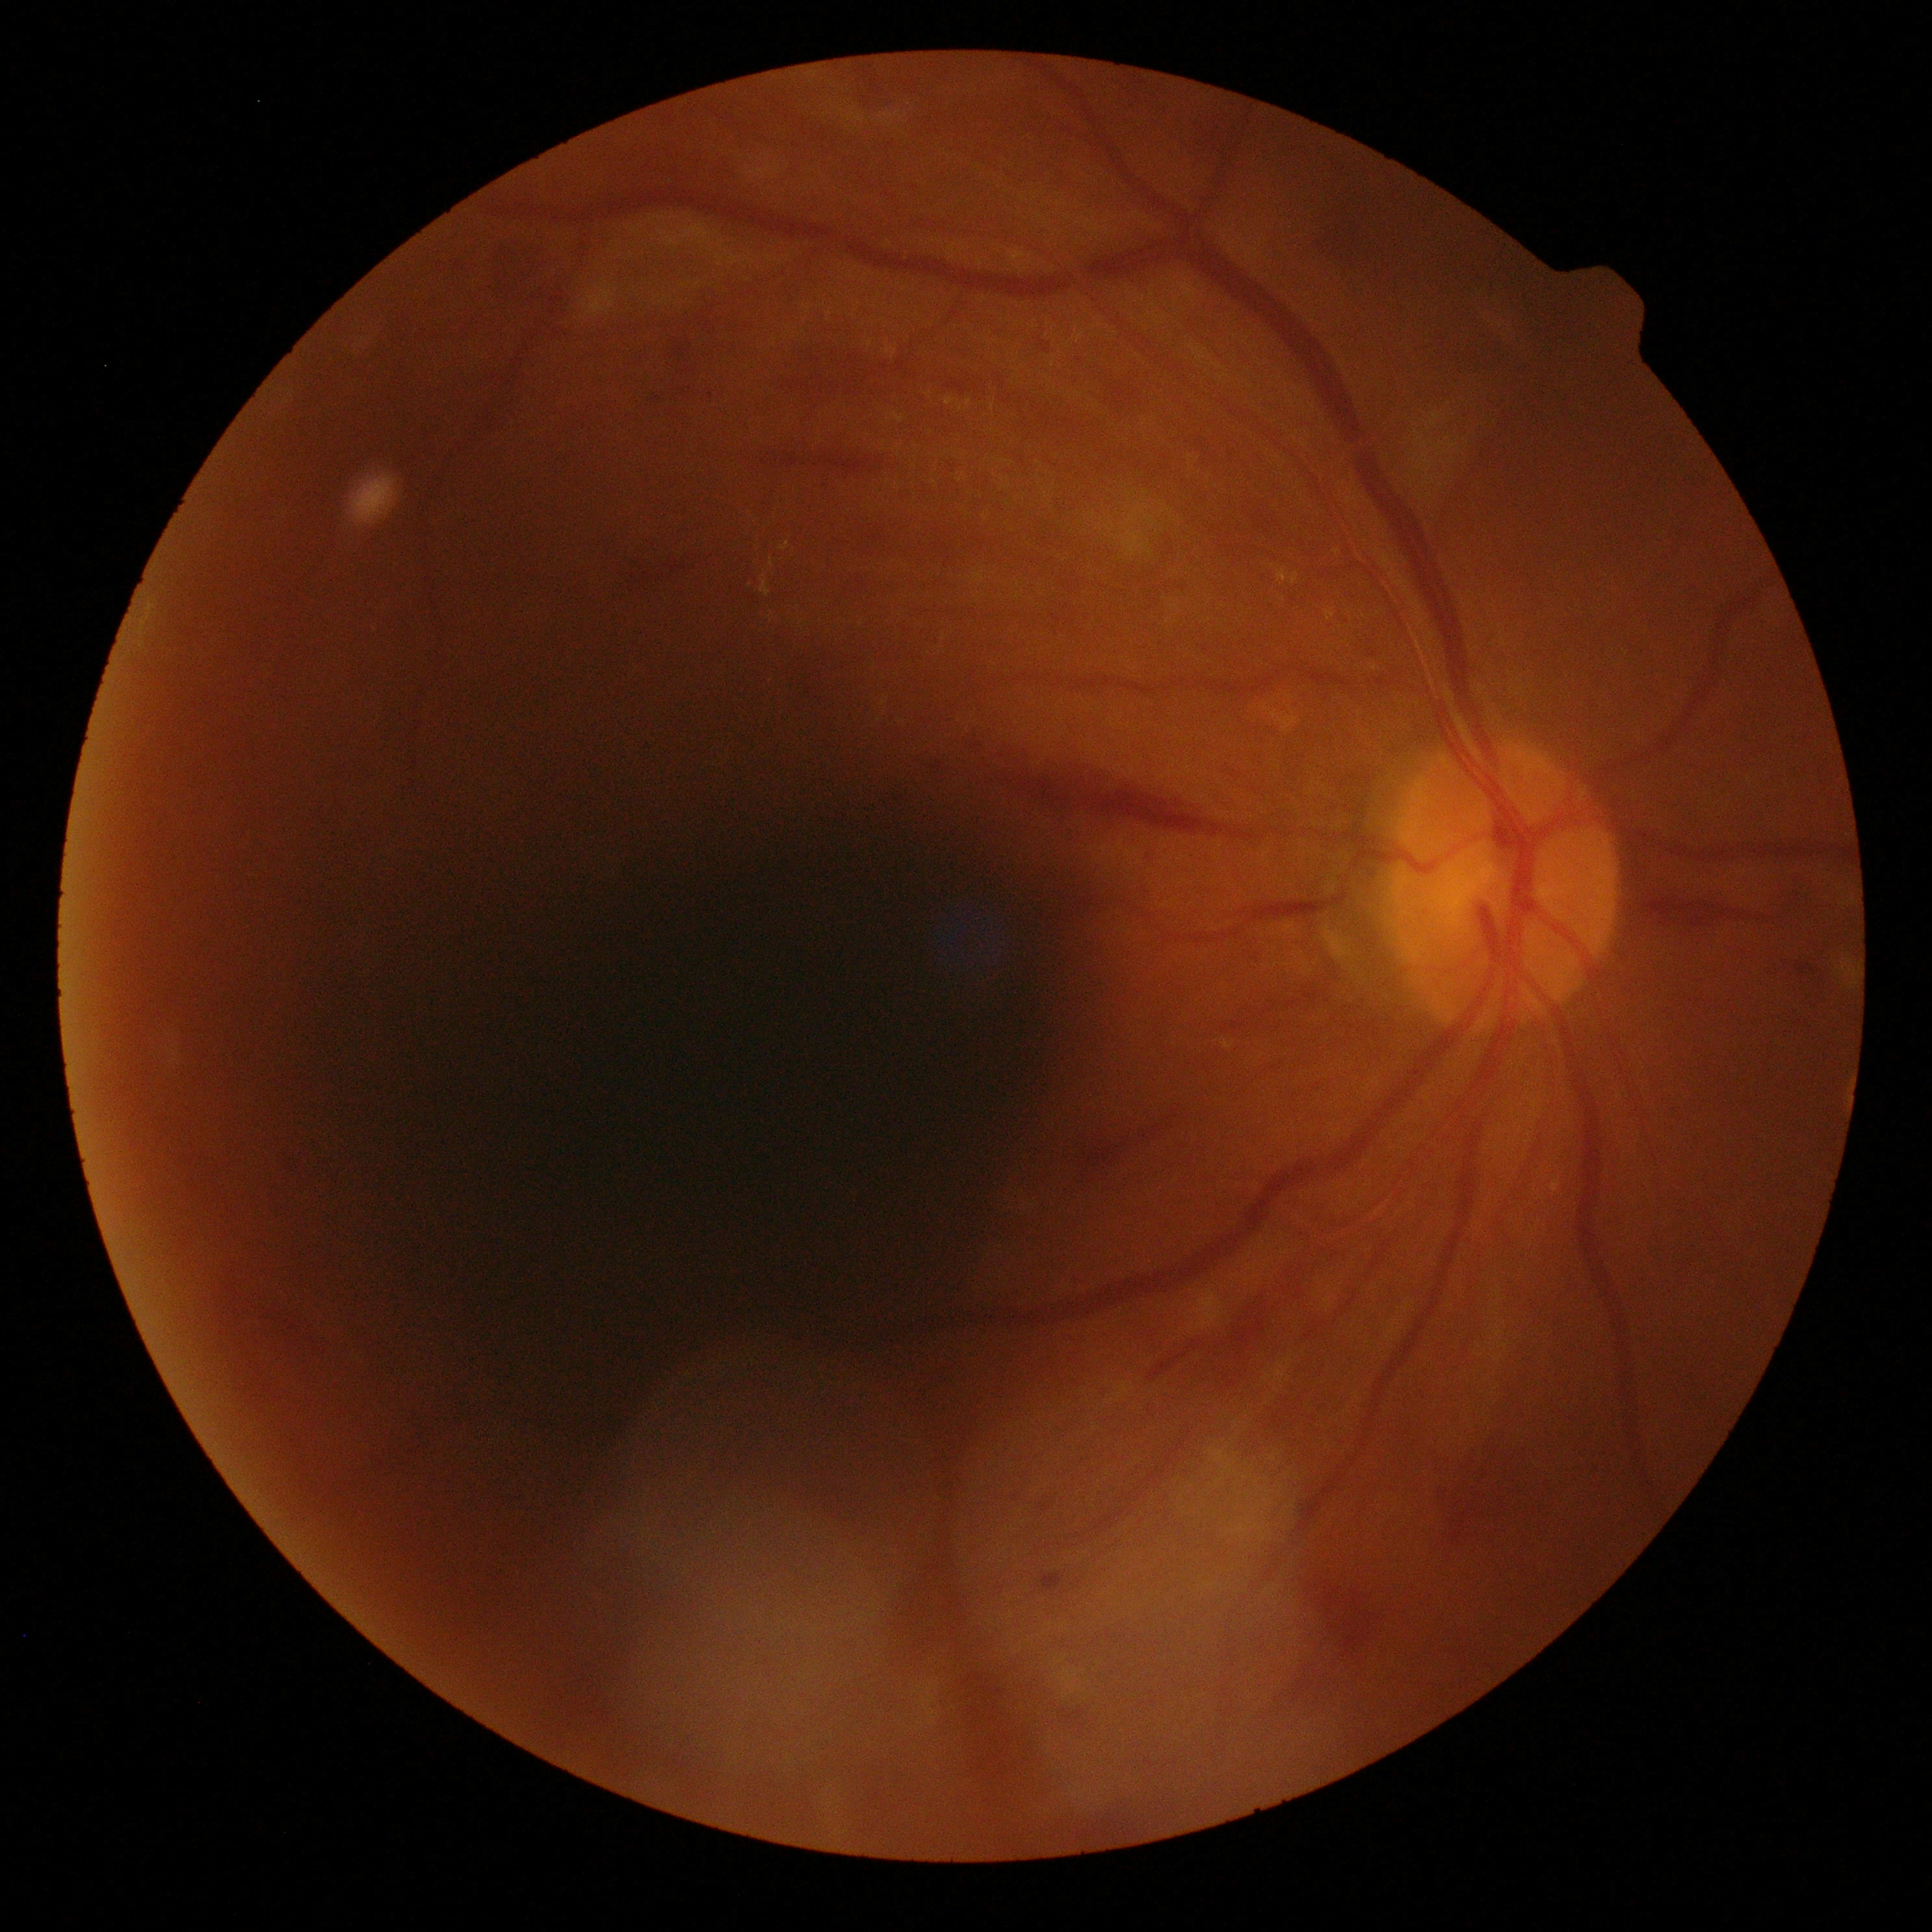 DR: grade 2 — more than just microaneurysms but less than severe NPDR.